Camera: Nidek AFC-330: 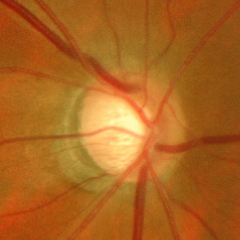

Findings consistent with glaucoma. Glaucoma status = advanced-stage glaucoma.